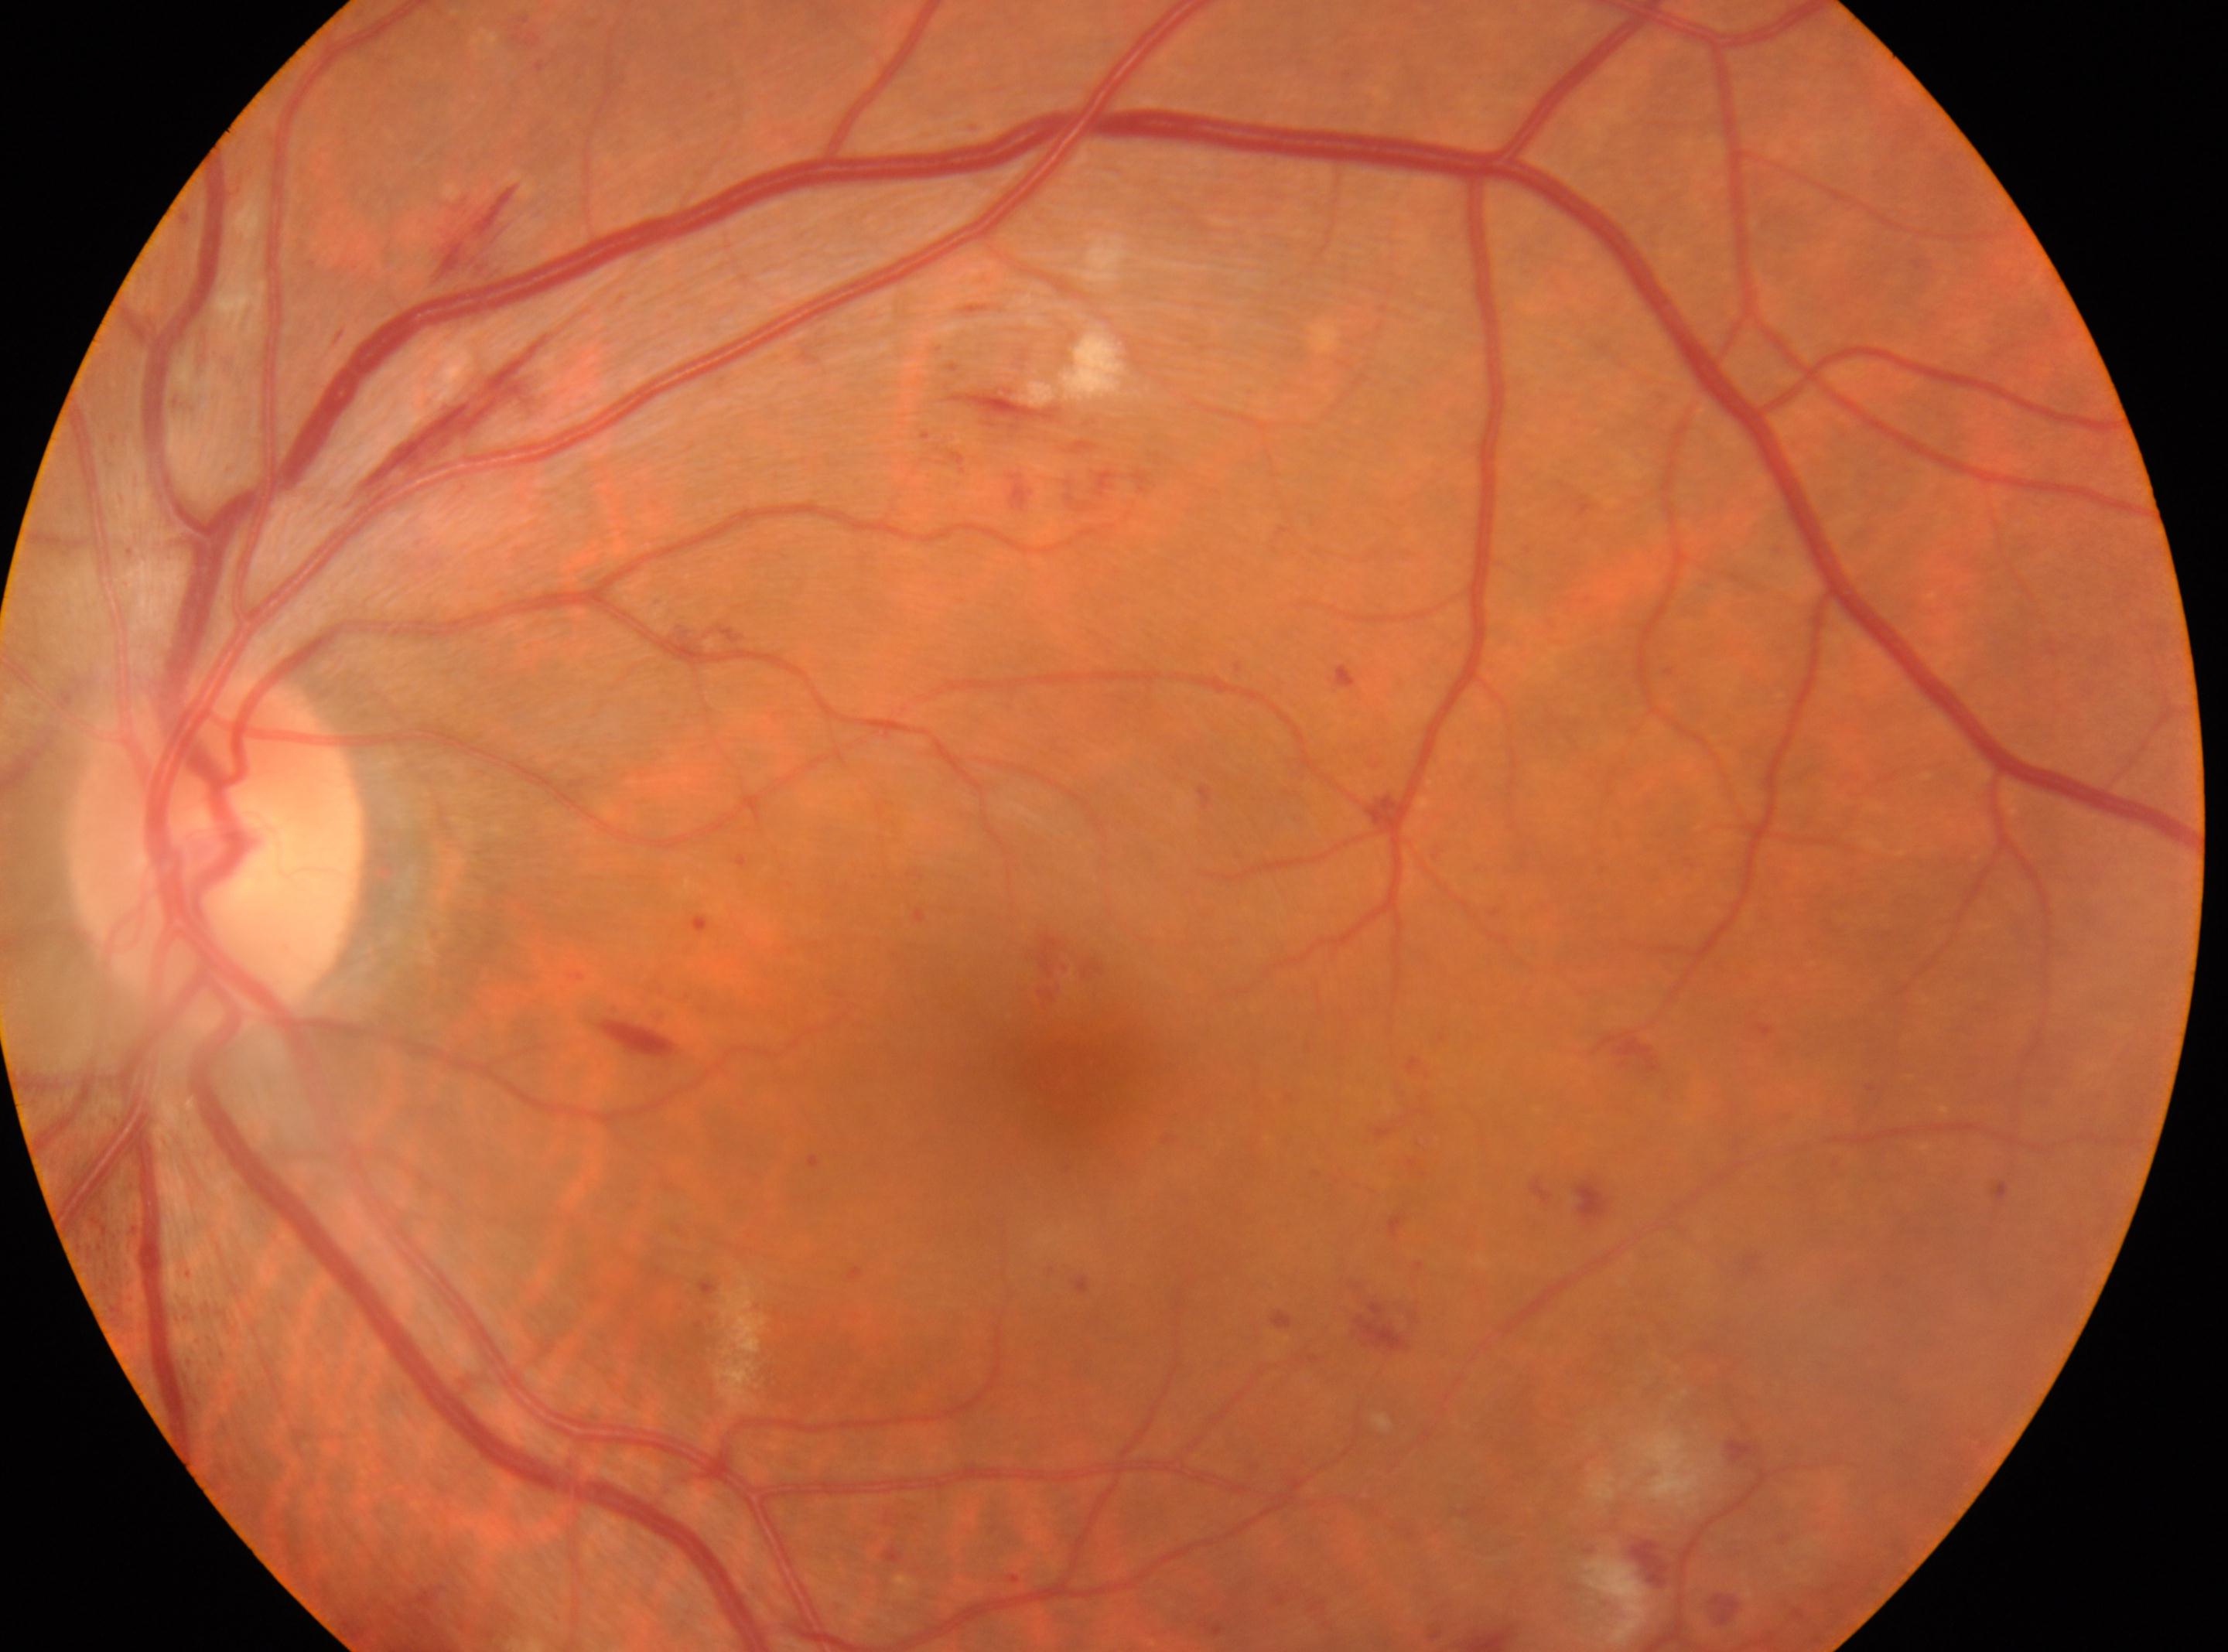

Q: DR stage?
A: grade 2
Q: Locate the optic disc.
A: (215, 854)
Q: Where is the fovea?
A: (1066, 1078)
Q: Right or left eye?
A: the left eye